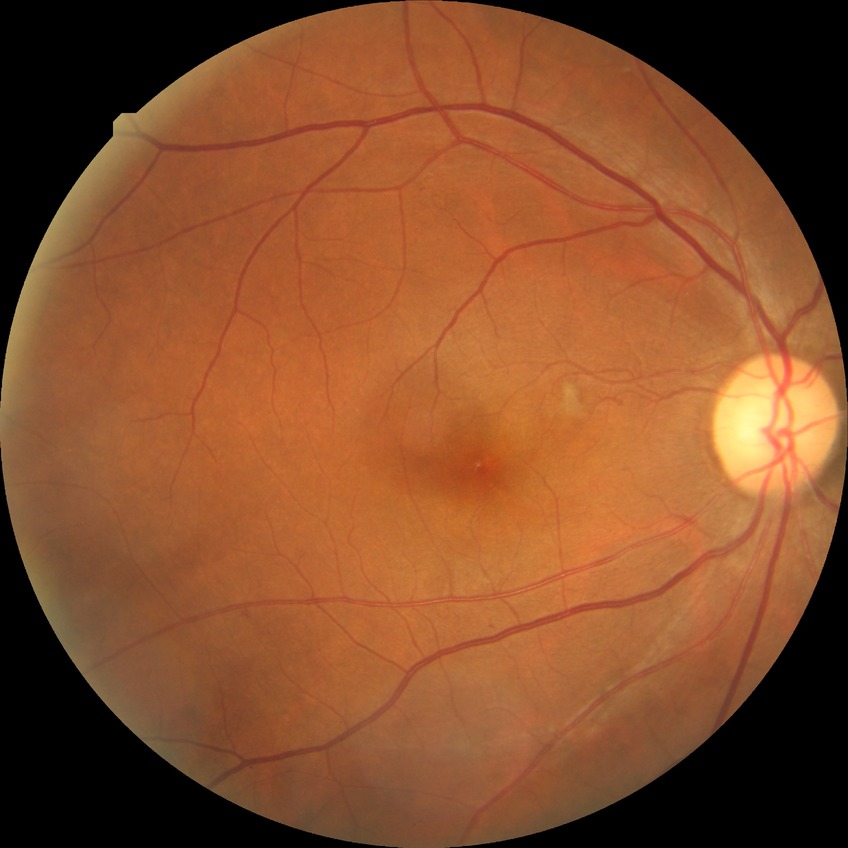
DR grade: PPDR.